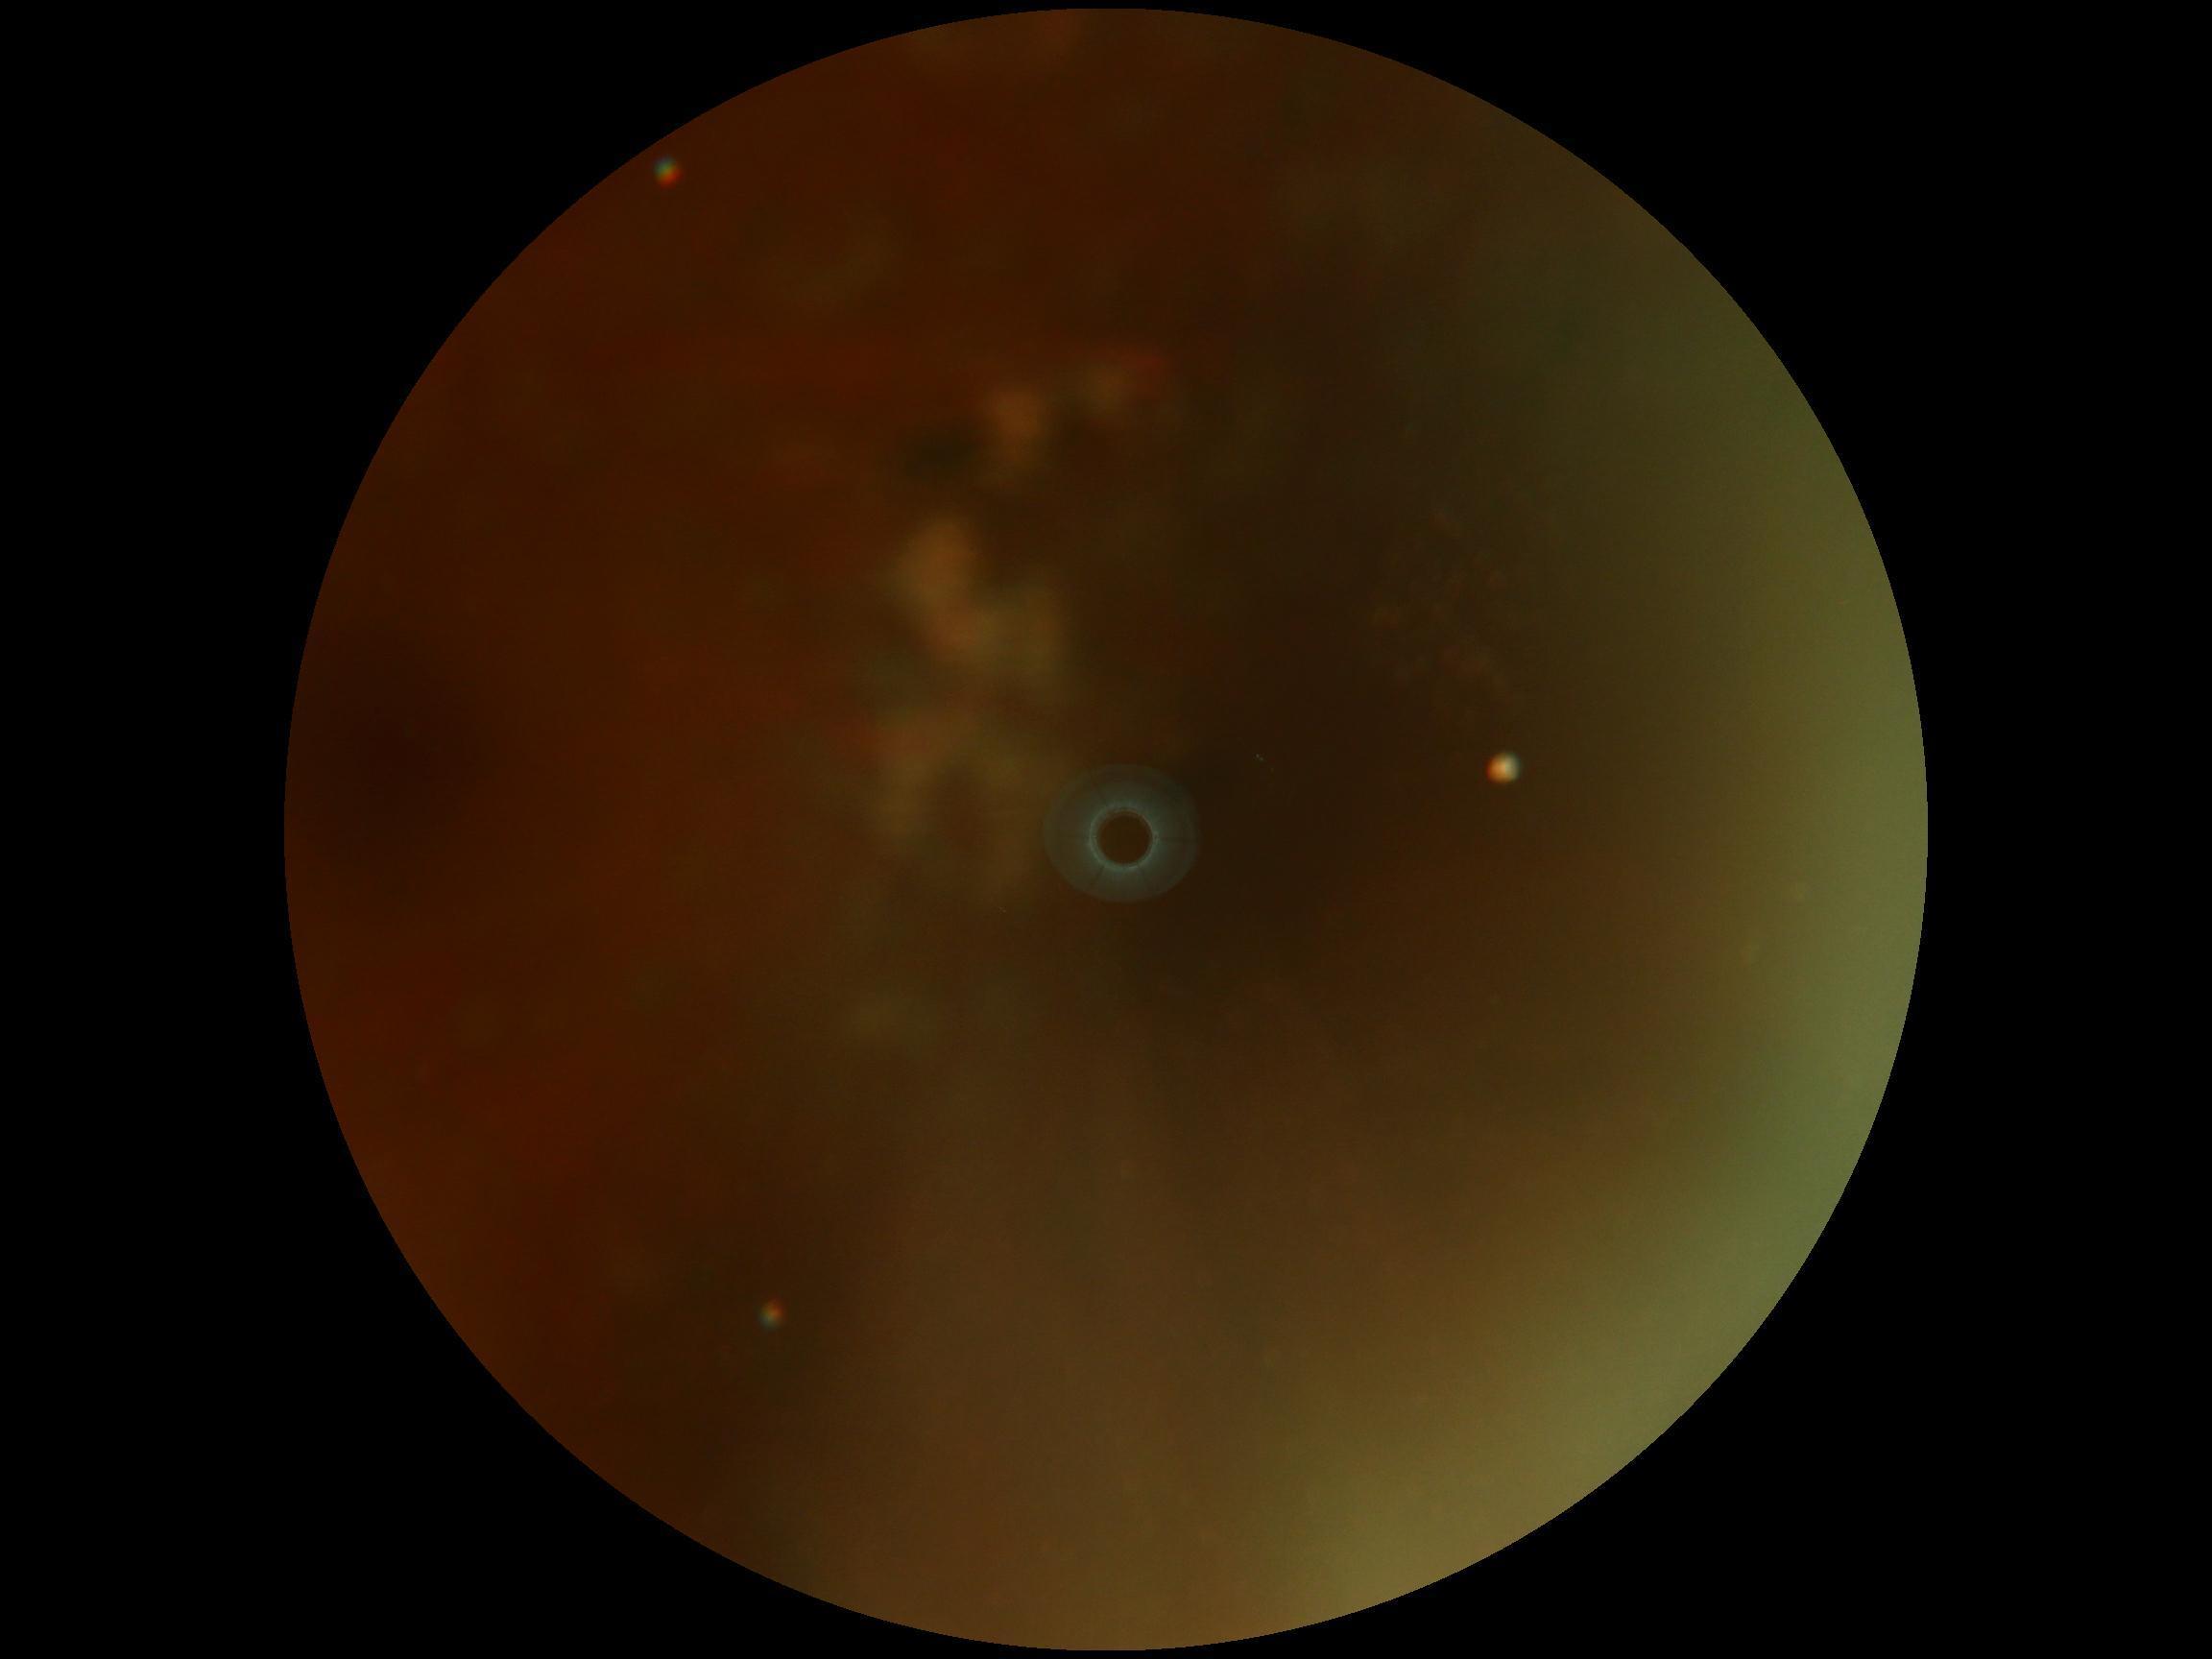

diabetic retinopathy grade: ungradable.